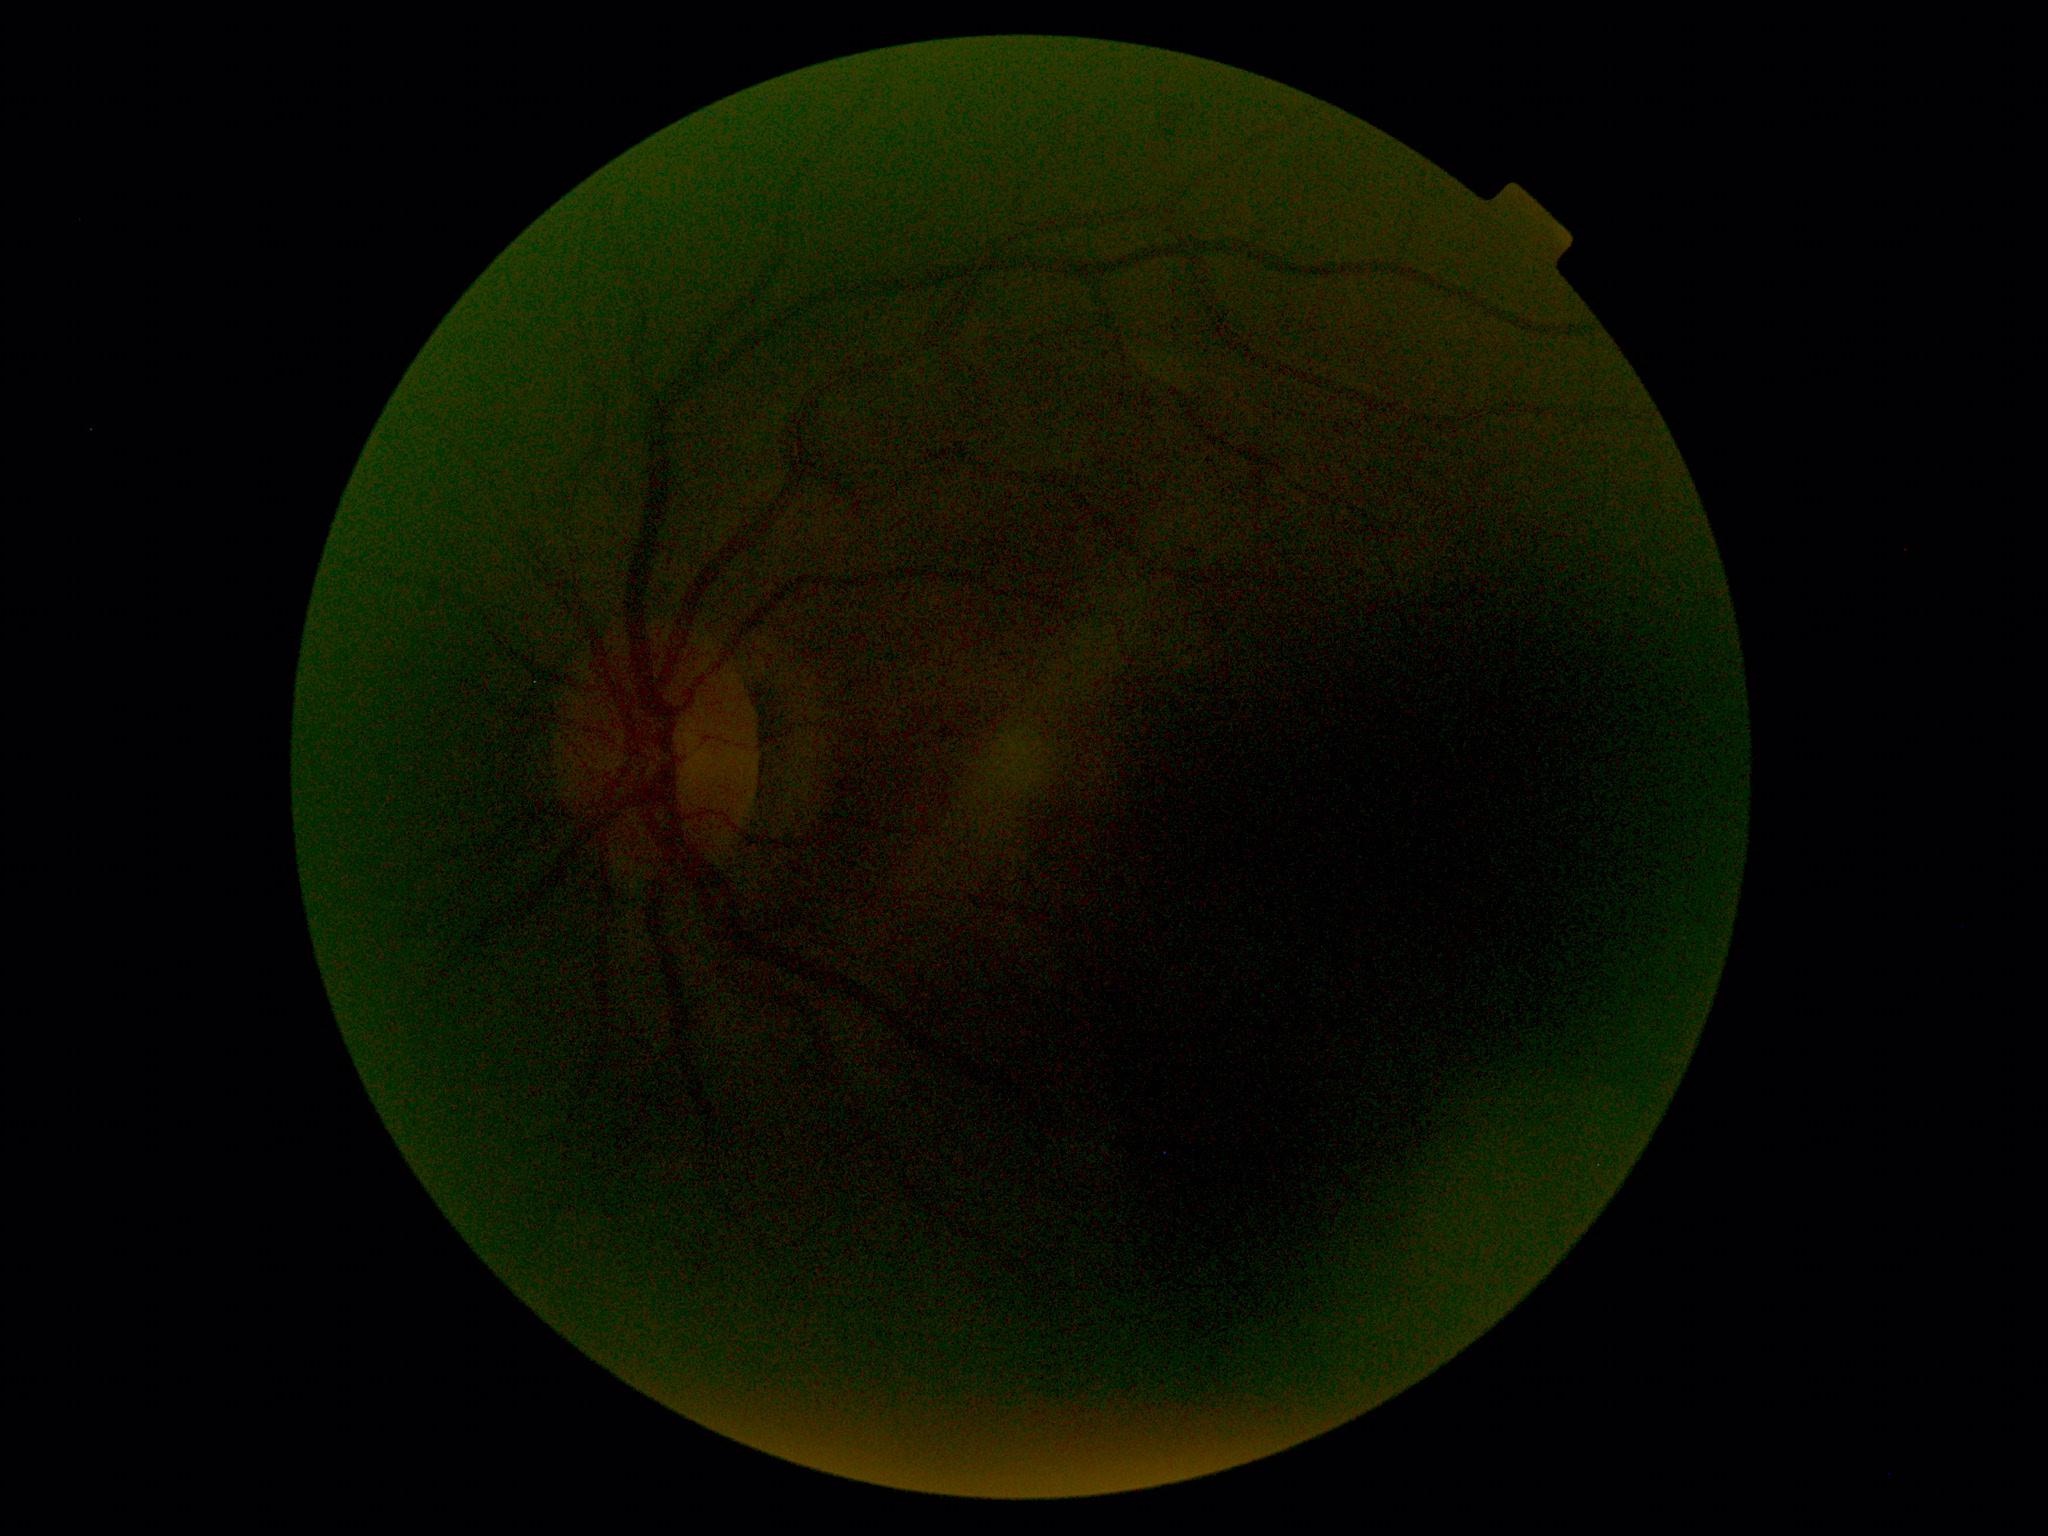
  quality: too poor for DR grading
  dr_grade: ungradable